Diabetic retinopathy graded by the modified Davis classification: 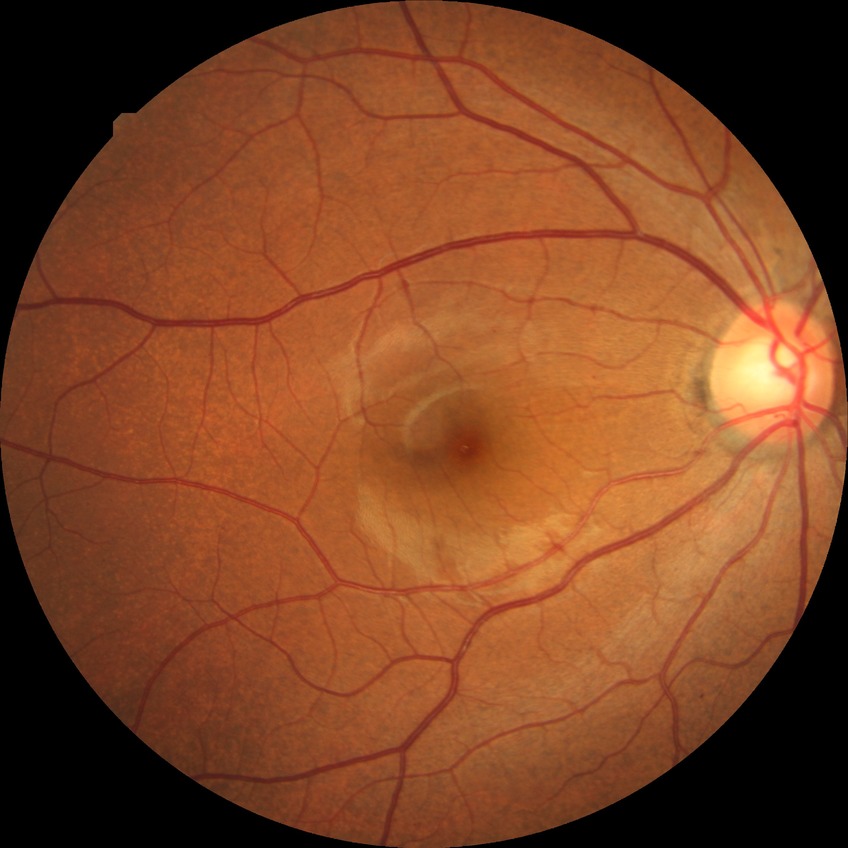 {
  "davis_grade": "SDR (simple diabetic retinopathy)"
}